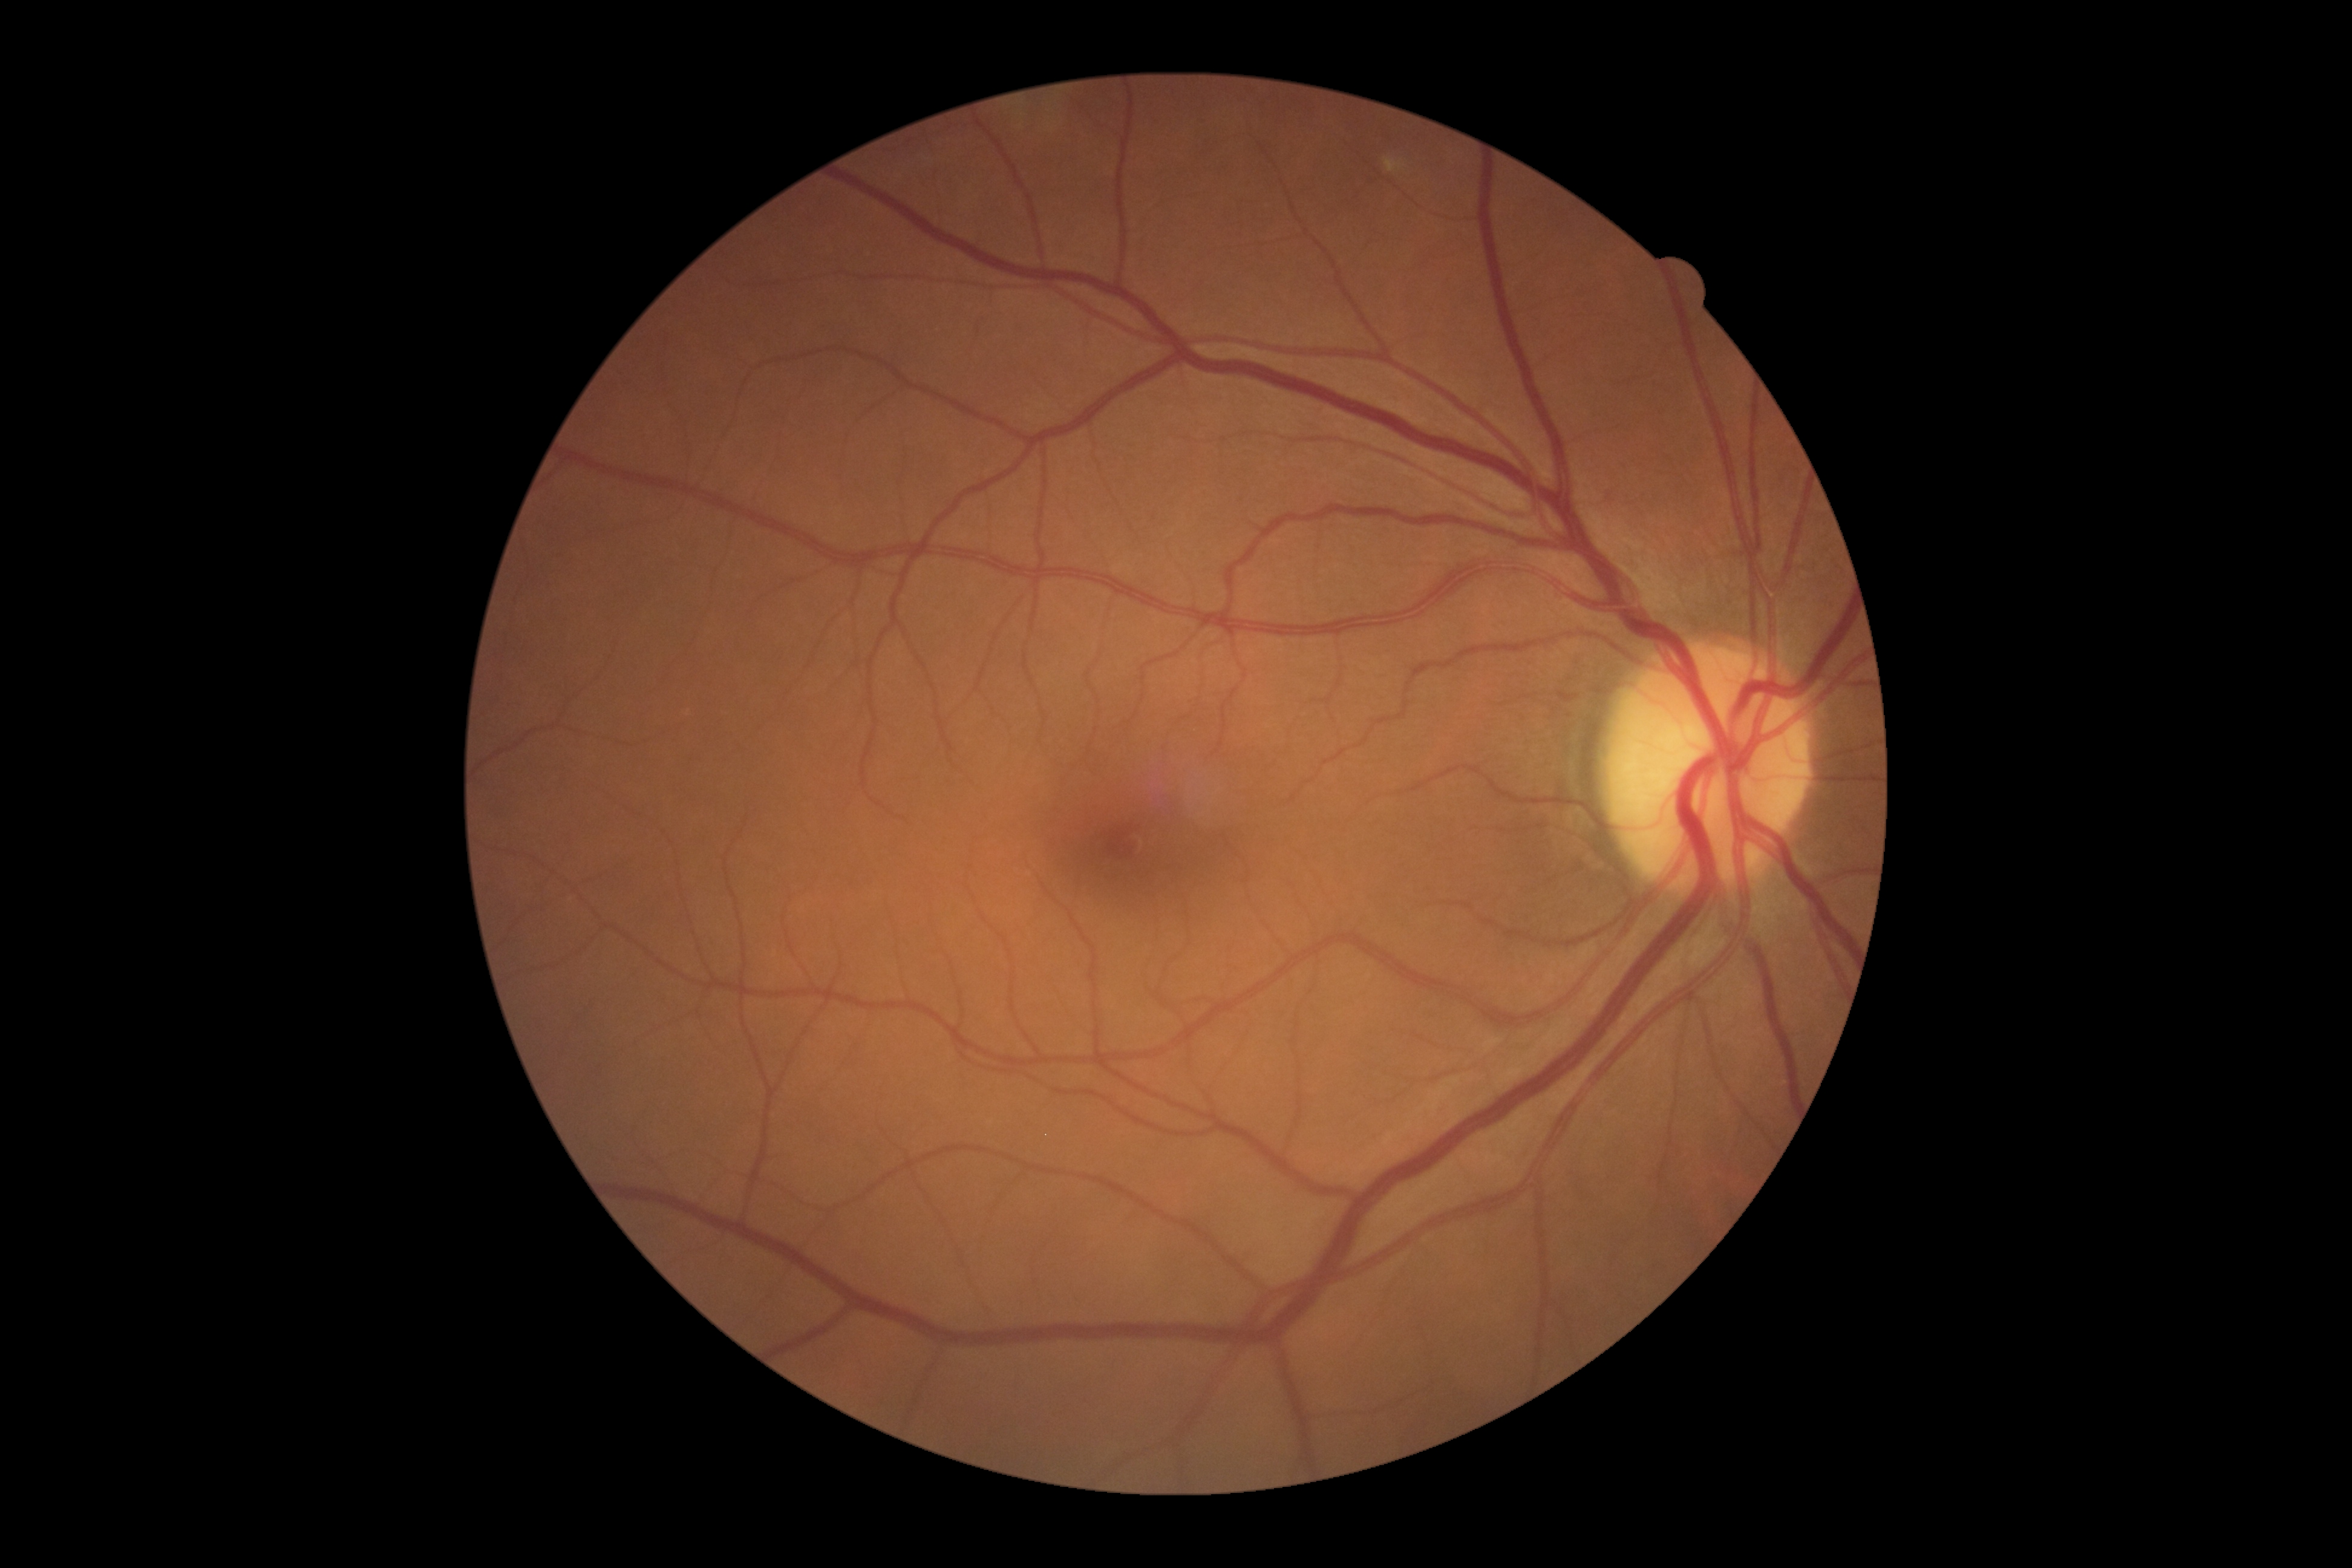

{
  "dr_grade": "0"
}